Image size 1380x1382.
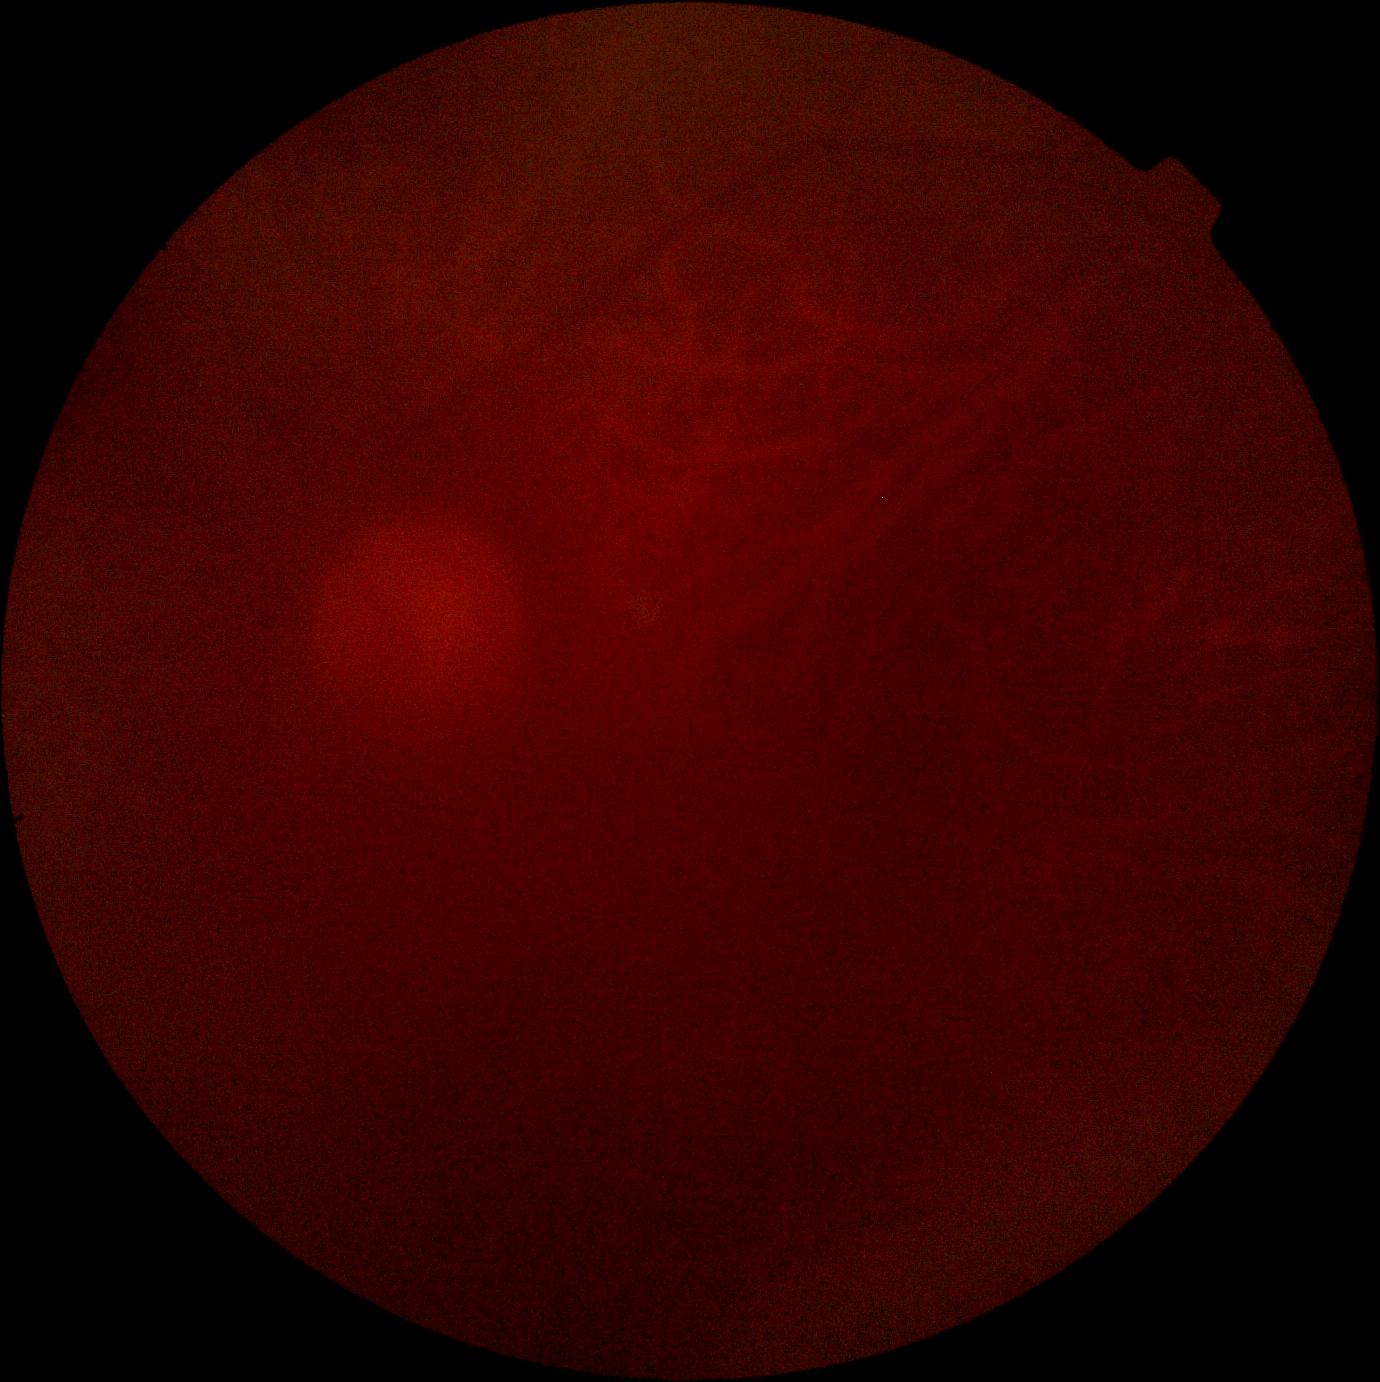
DR grade is ungradable.